Retinal fundus photograph
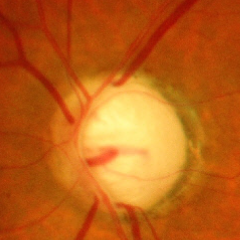

Glaucomatous changes are present. The image shows advanced glaucoma.